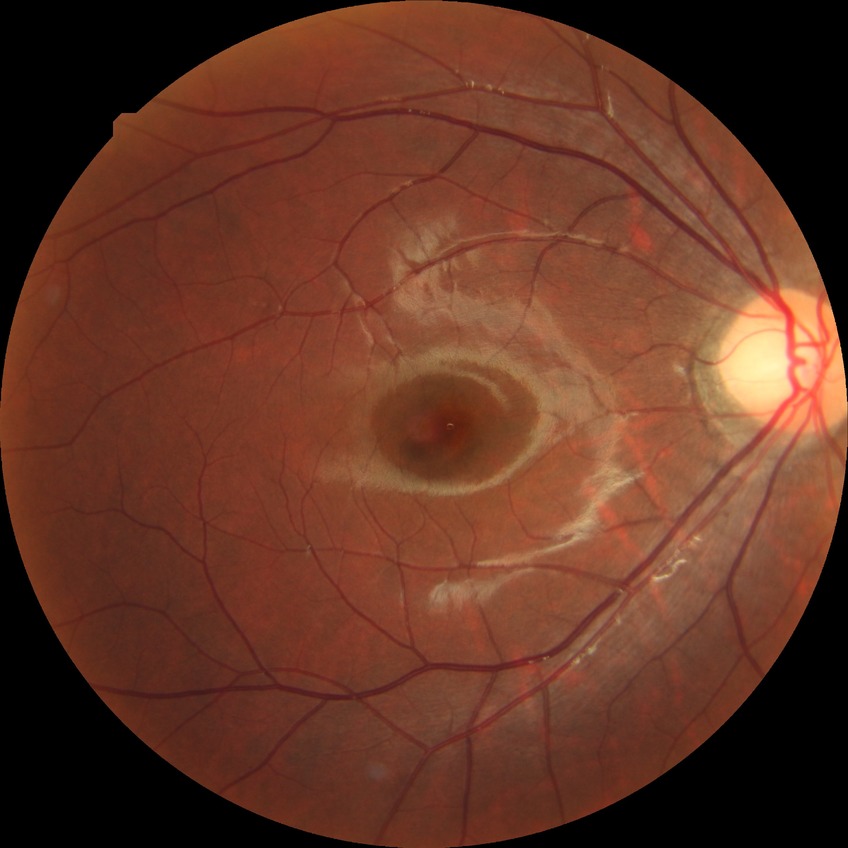 Diabetic retinopathy (DR) is no diabetic retinopathy (NDR).